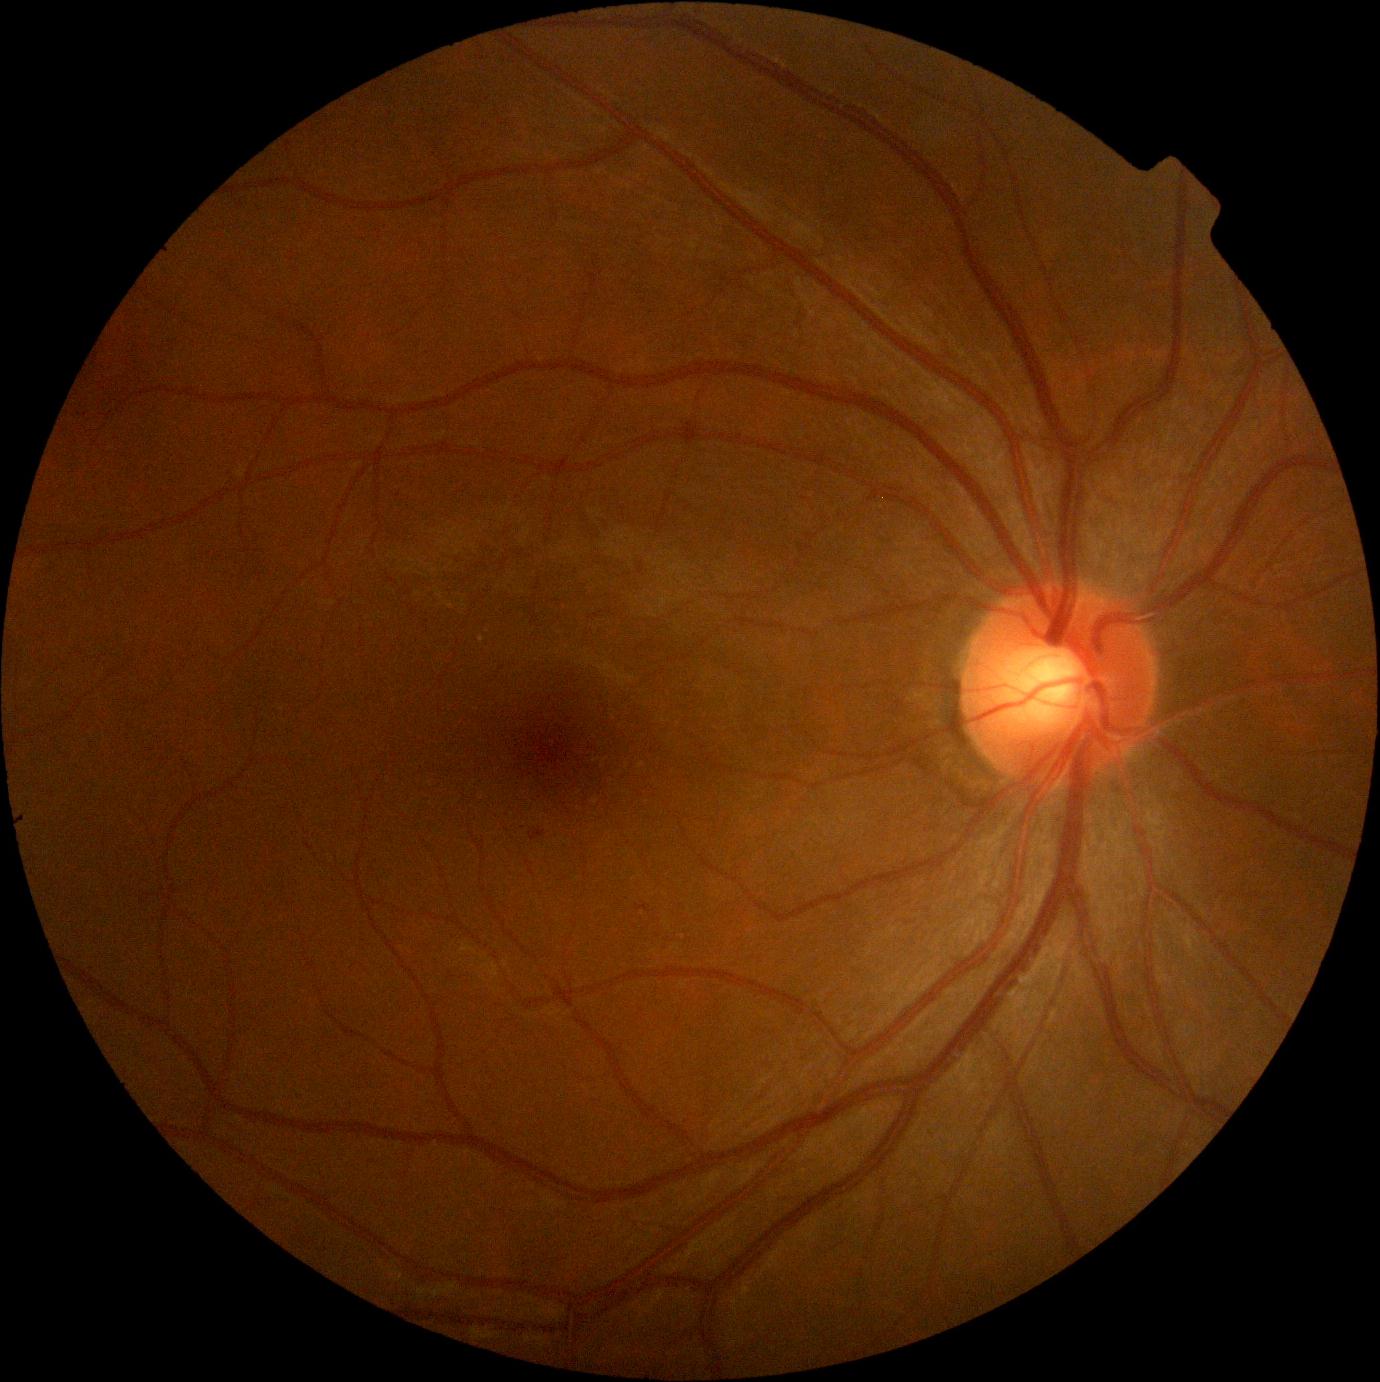 DR stage: grade 1 (mild NPDR).